Posterior pole color fundus photograph. Modified Davis grading. 45-degree field of view:
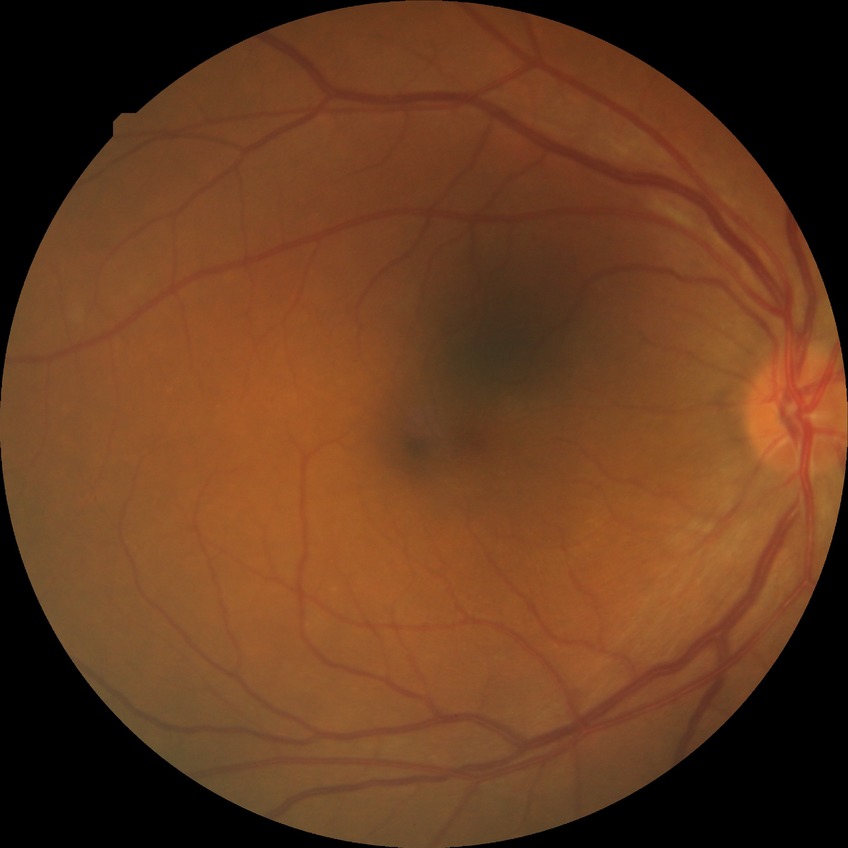

Assessment:
• diabetic retinopathy (DR): SDR (simple diabetic retinopathy)